CFP. FOV: 45 degrees.
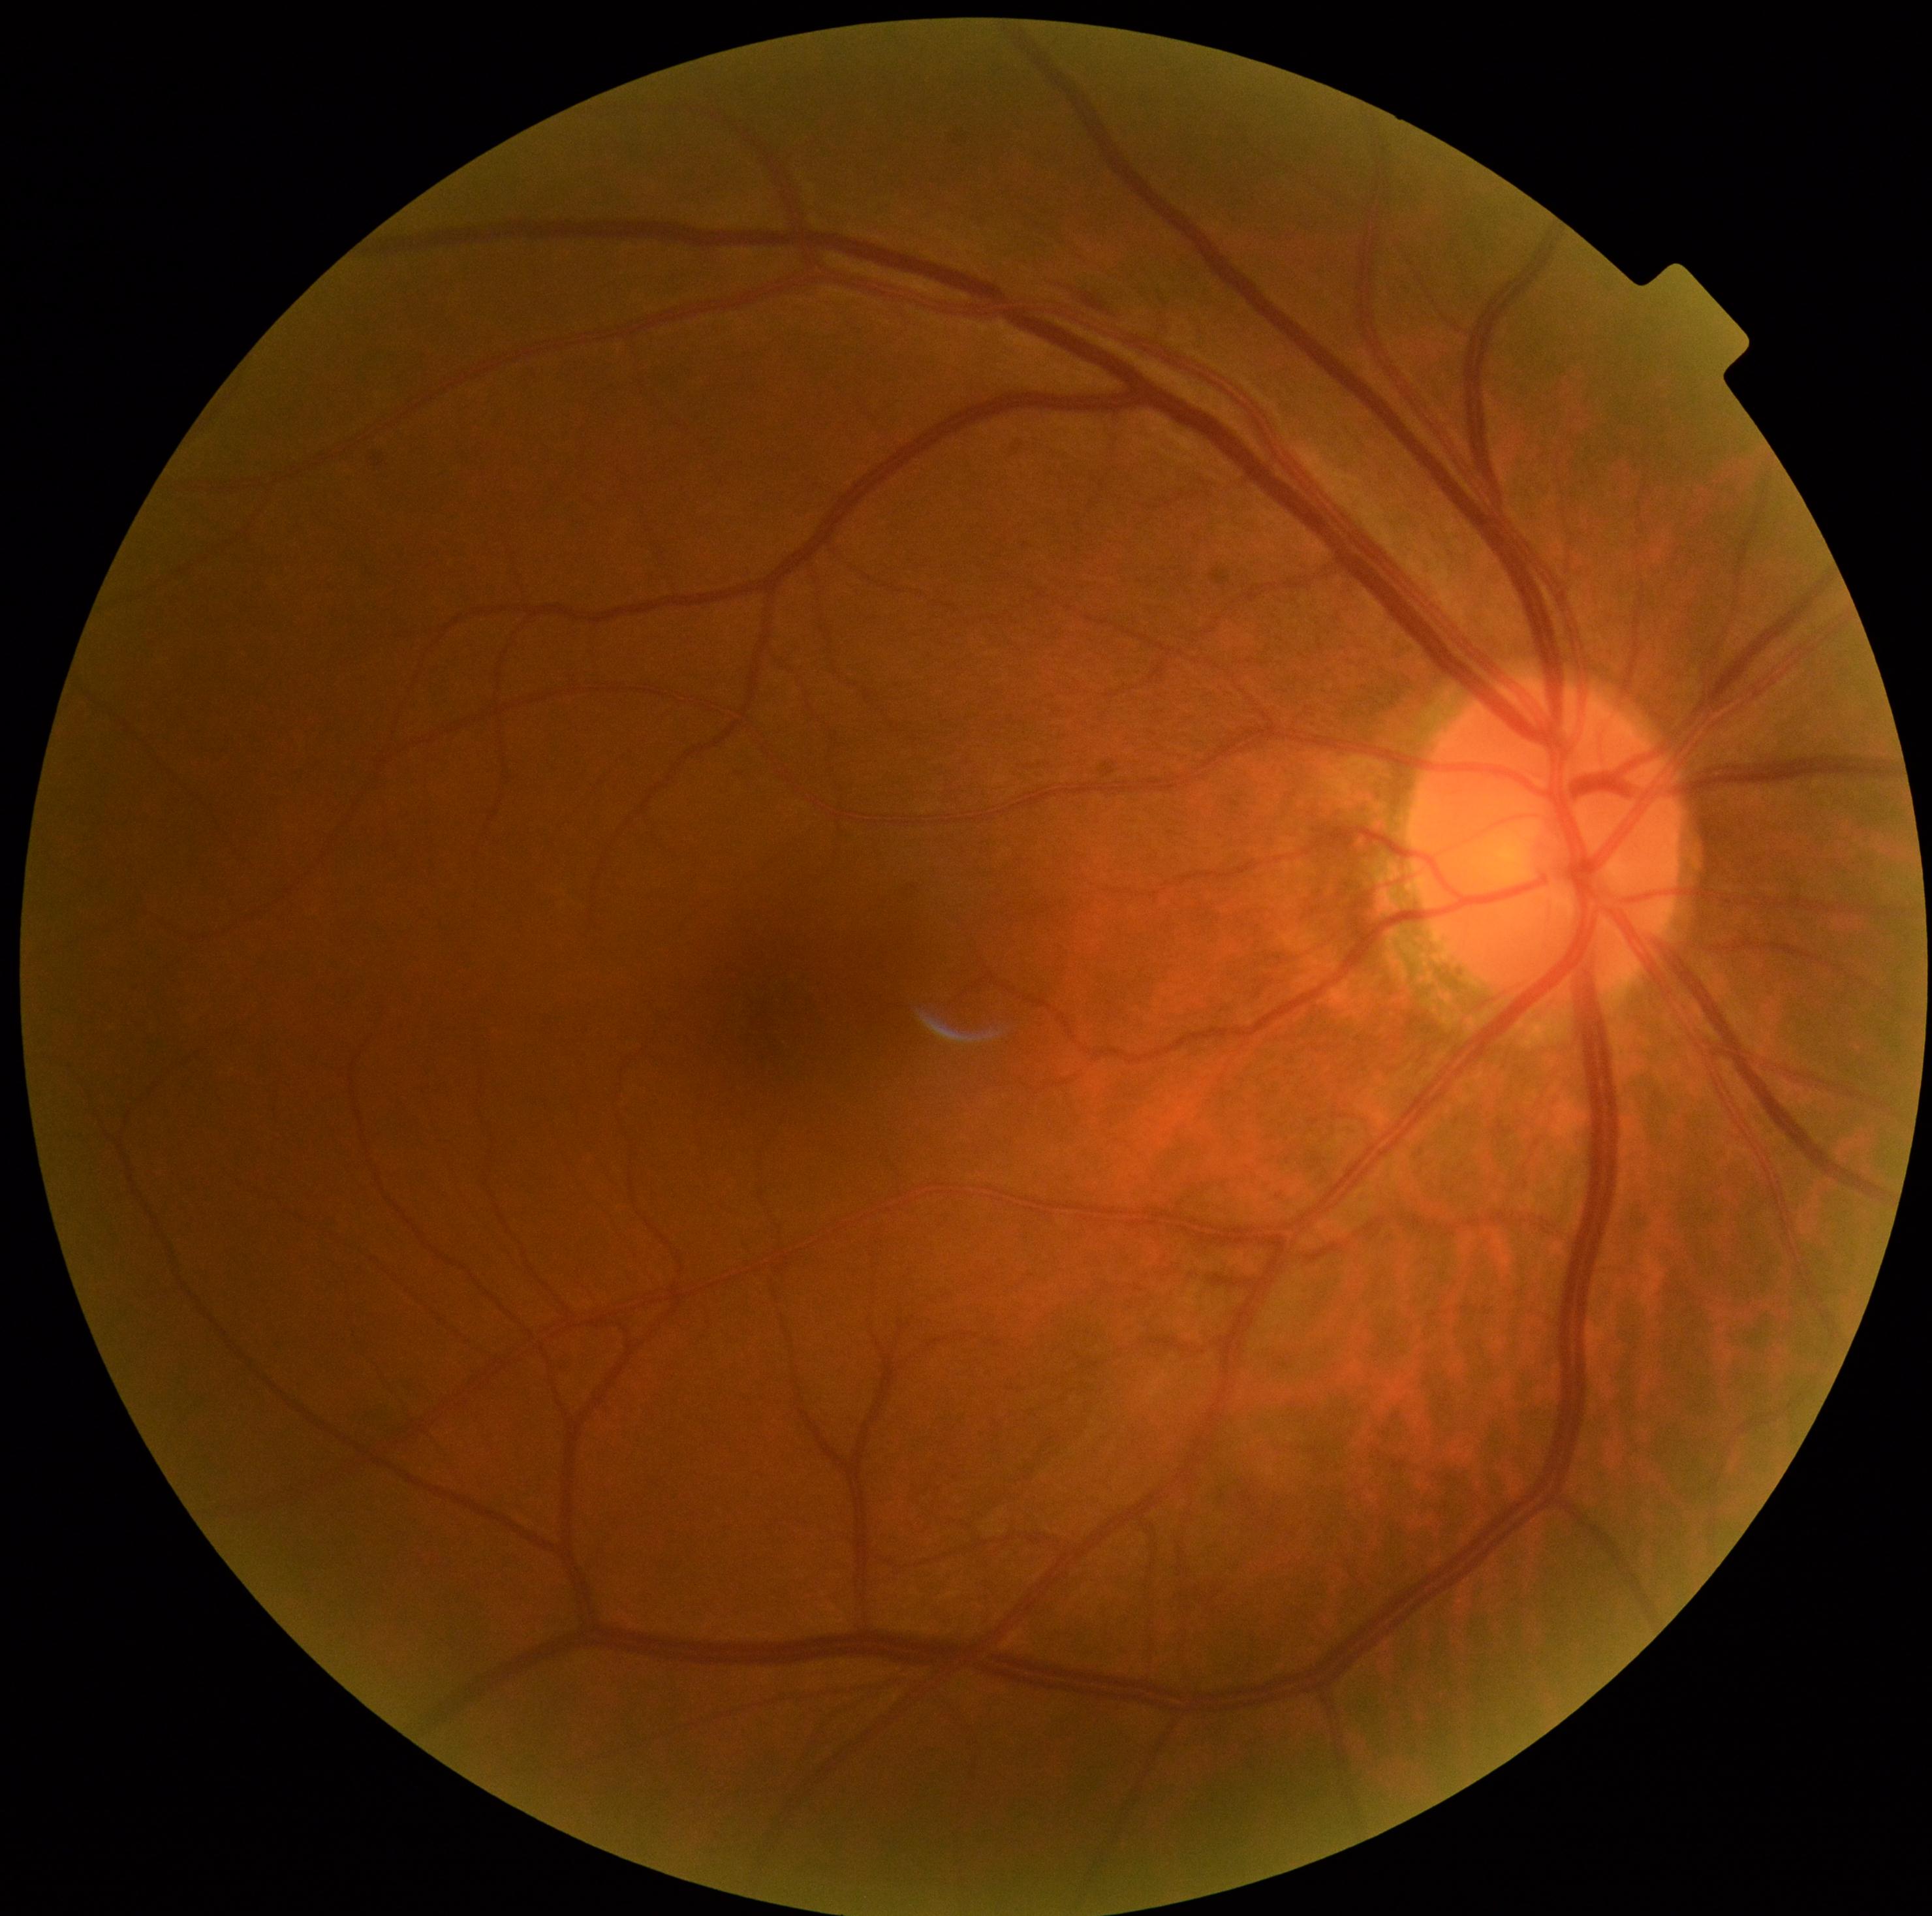 DR: grade 2.